No pharmacologic dilation.
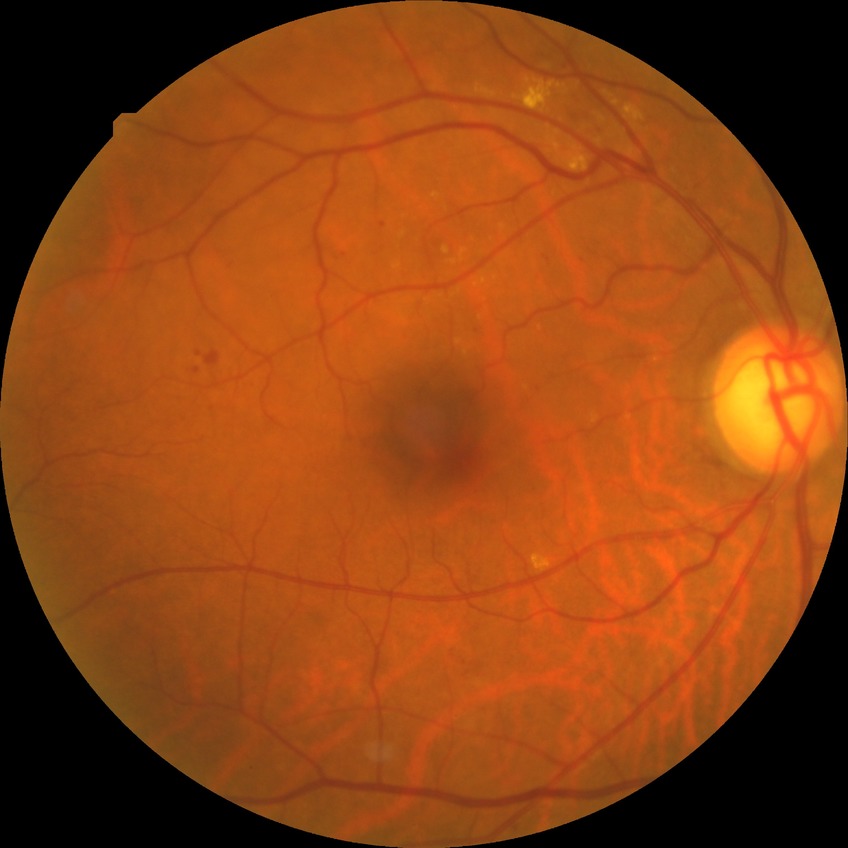
  davis_grade: SDR (simple diabetic retinopathy)